Non-mydriatic fundus camera — 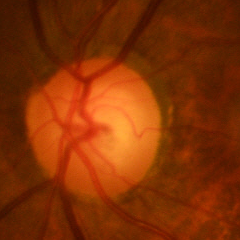

Q: Glaucoma assessment?
A: No evidence of glaucoma.